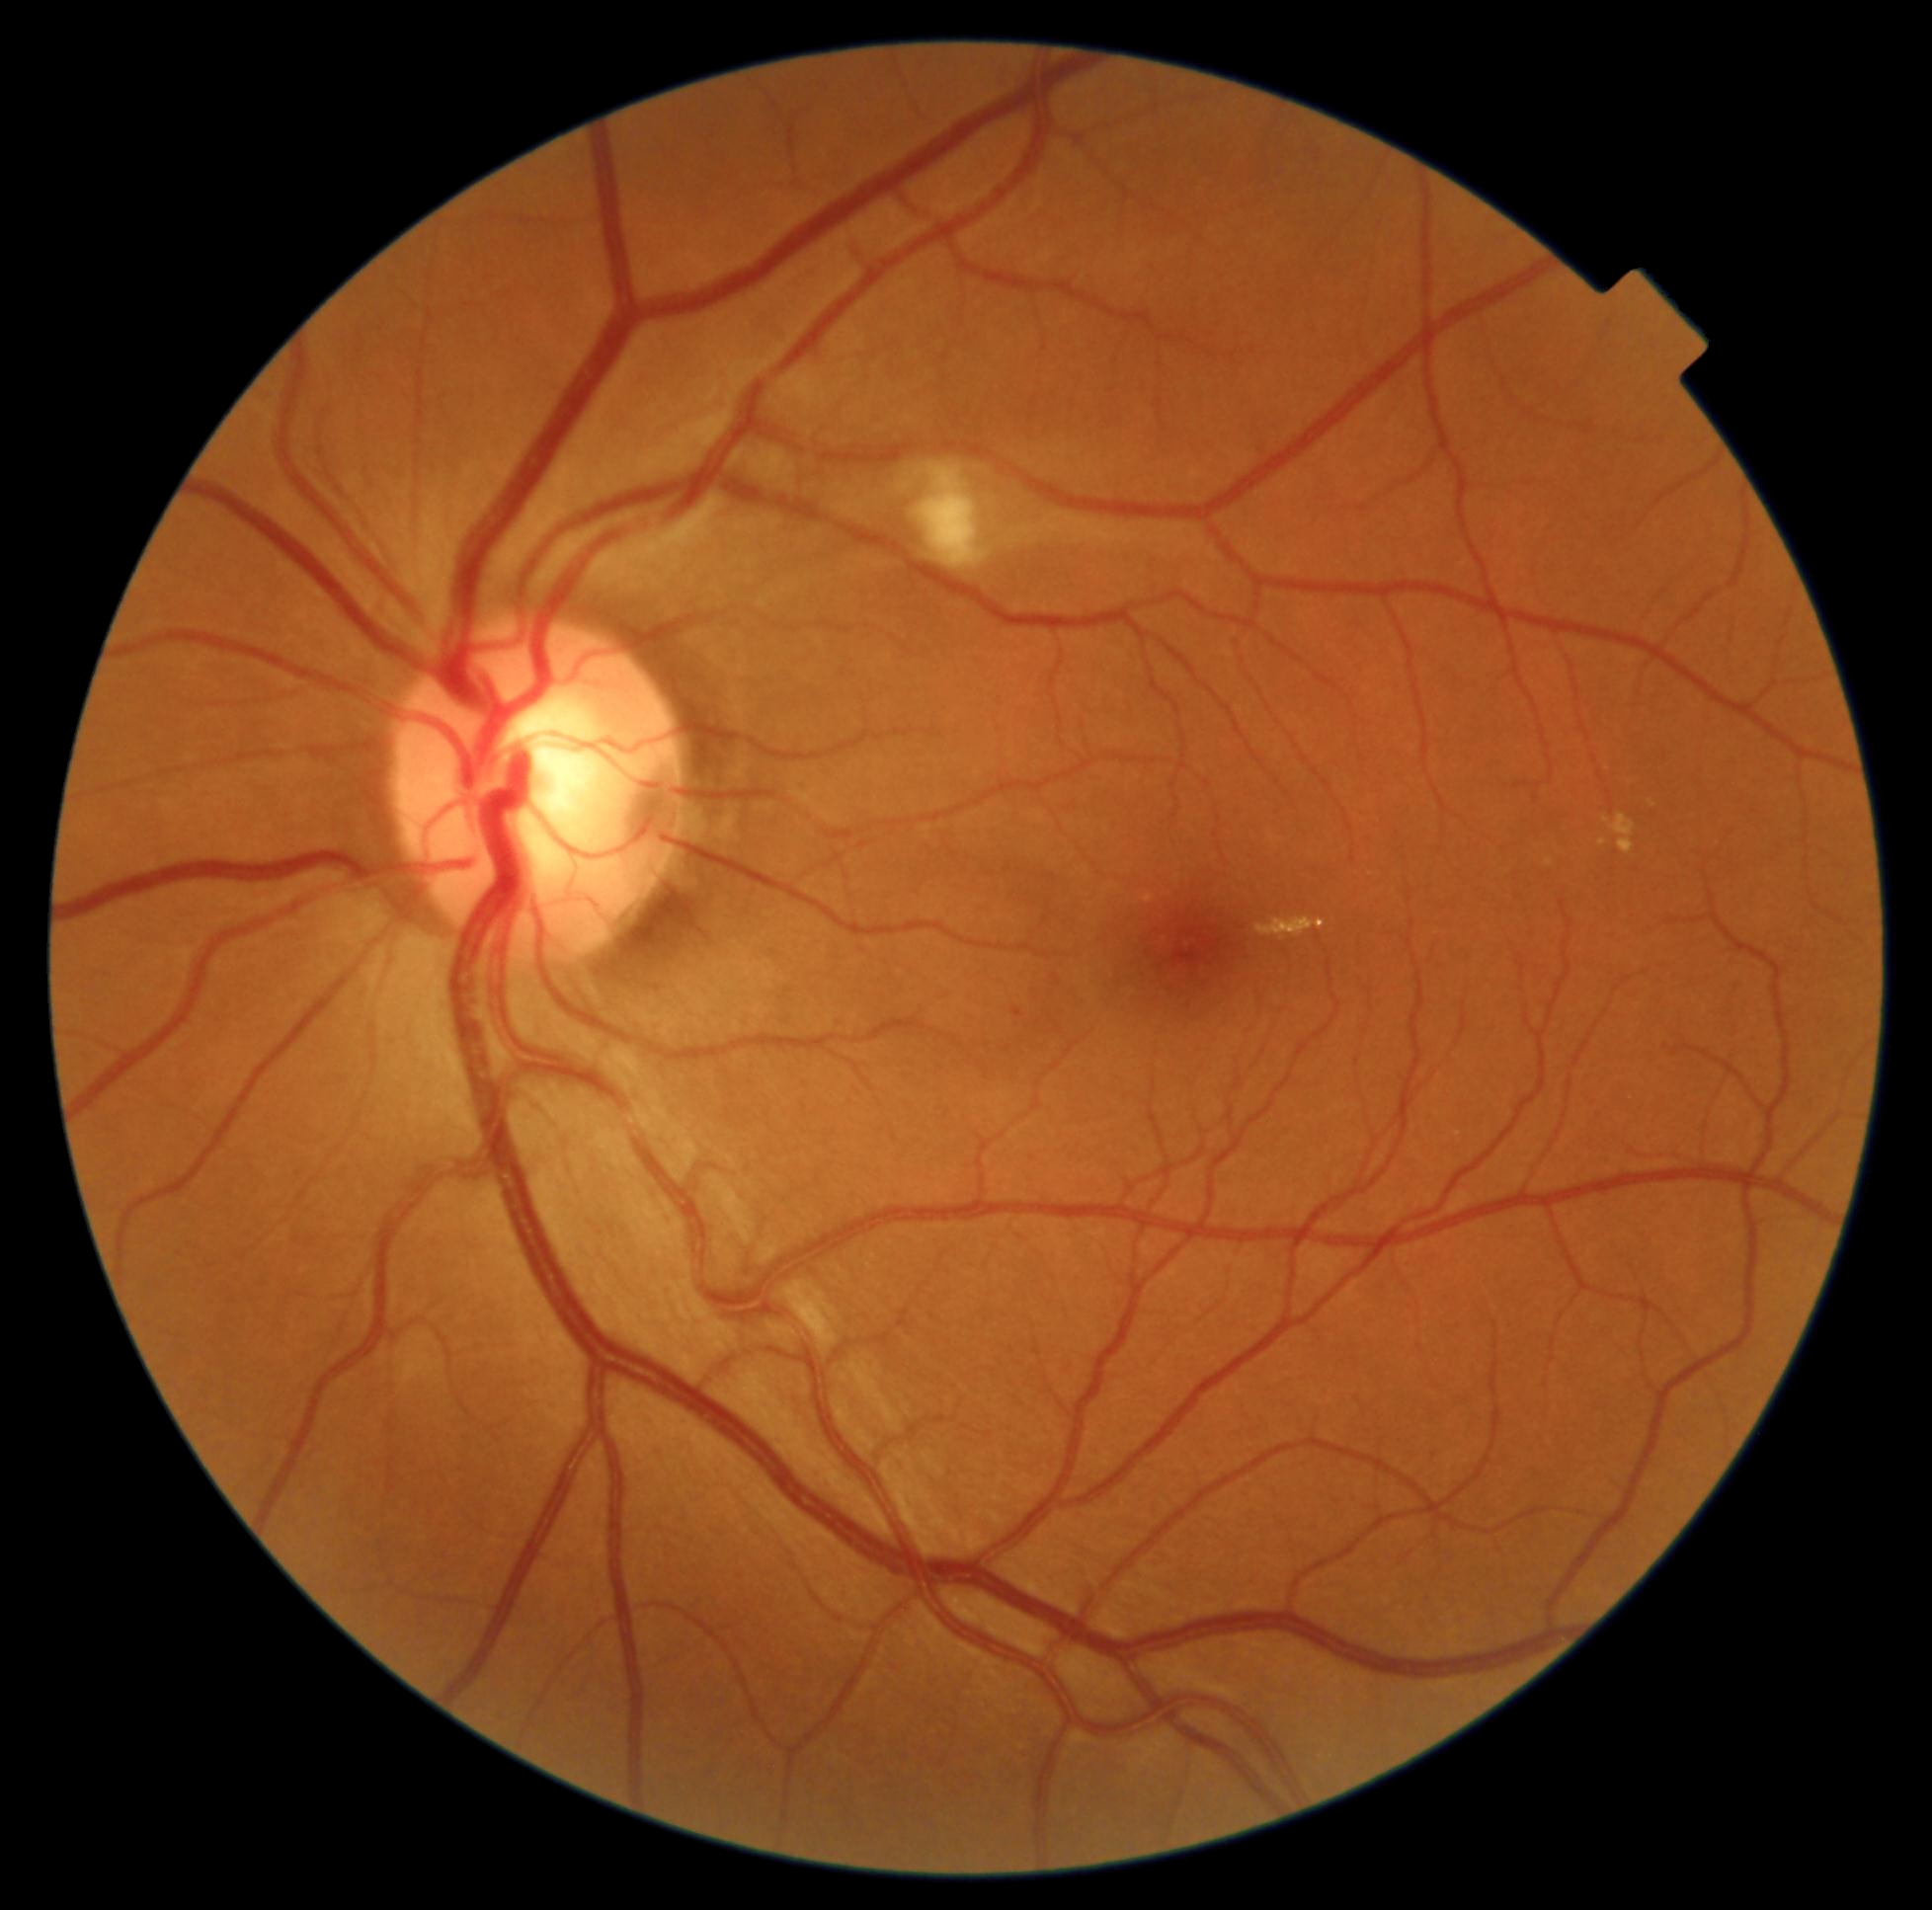

{"dr_grade": 2, "dr_grade_name": "moderate NPDR", "lesions": {"he": null, "ex": [[1256, 917, 1327, 942], [1545, 858, 1554, 867], [1610, 815, 1637, 854], [1604, 817, 1611, 825], [1599, 840, 1608, 847]], "ex_small_centers": [[1653, 804]], "ma": [[1672, 1048, 1681, 1058], [1012, 1008, 1023, 1018]], "se": [[912, 462, 991, 572]]}}